Posterior pole color fundus photograph. FOV: 45 degrees
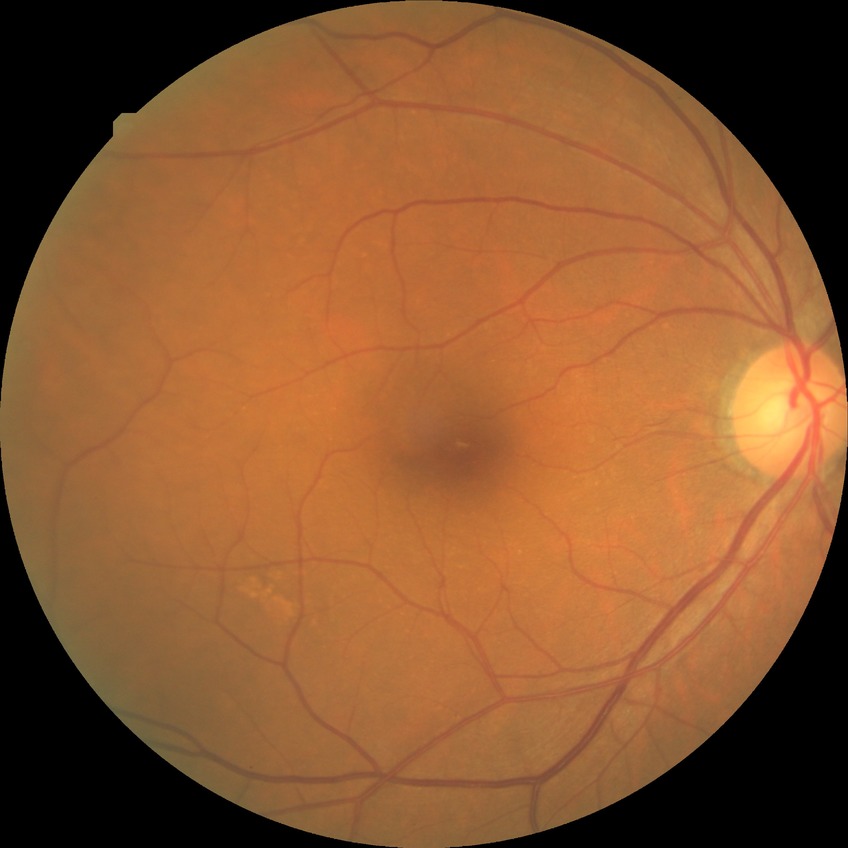 Retinopathy stage: no diabetic retinopathy.